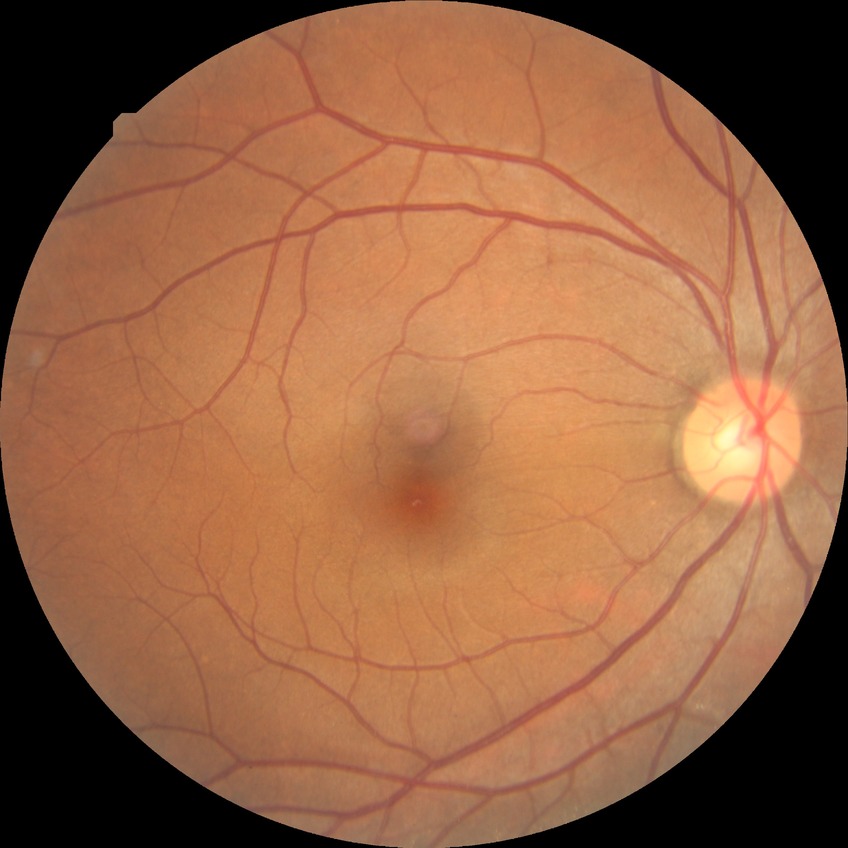
Retinopathy stage: no diabetic retinopathy.